Pediatric wide-field fundus photograph: 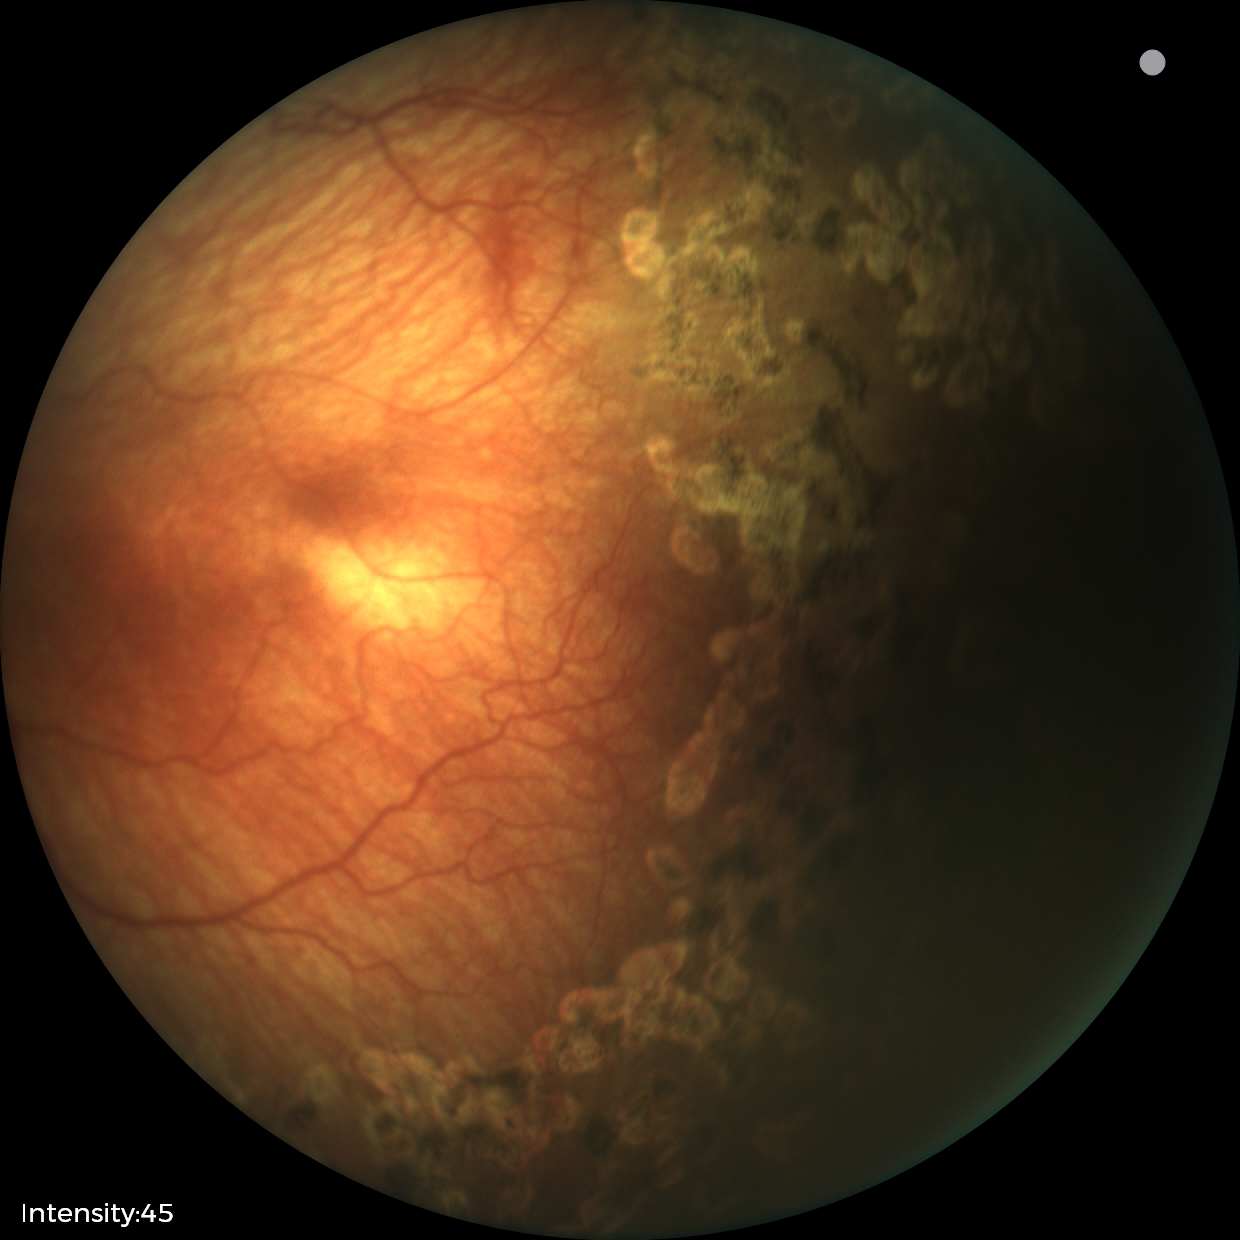
Q: What is the diagnosis from this examination?
A: status post ROP